45° field of view · retinal fundus photograph:
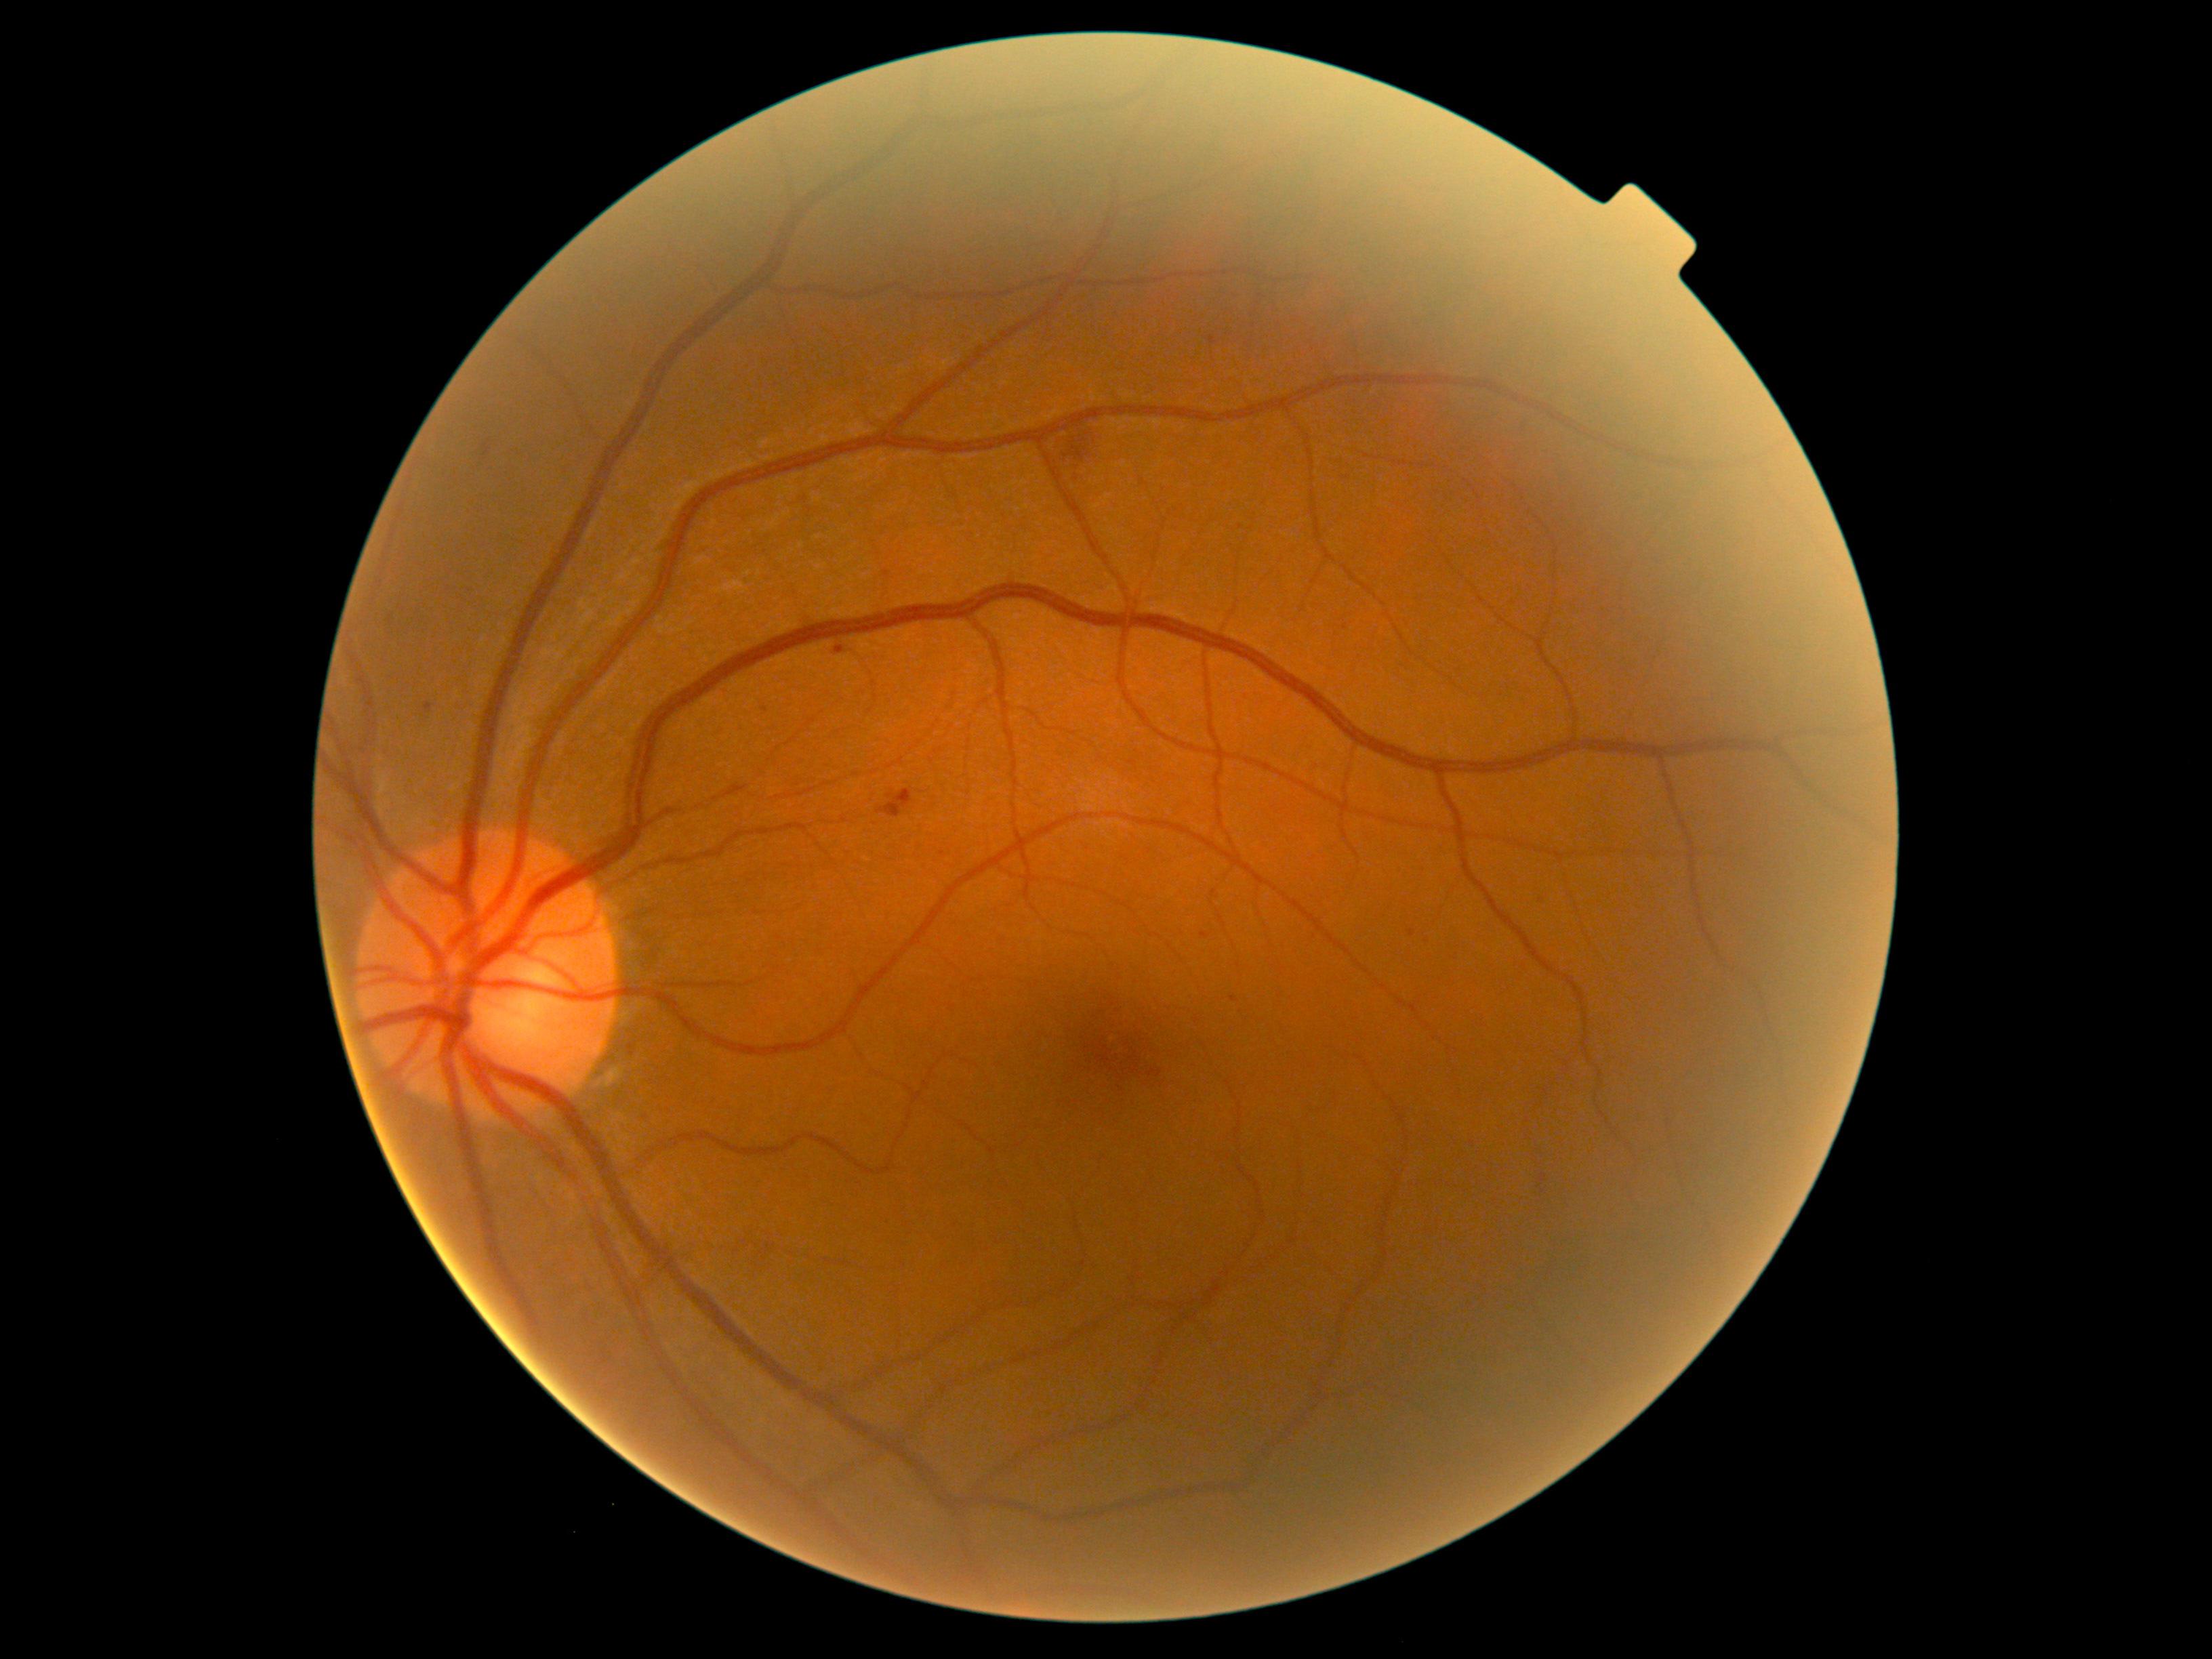

The retinopathy is classified as non-proliferative diabetic retinopathy. Diabetic retinopathy (DR) is grade 2 (moderate NPDR).